2352x1568px
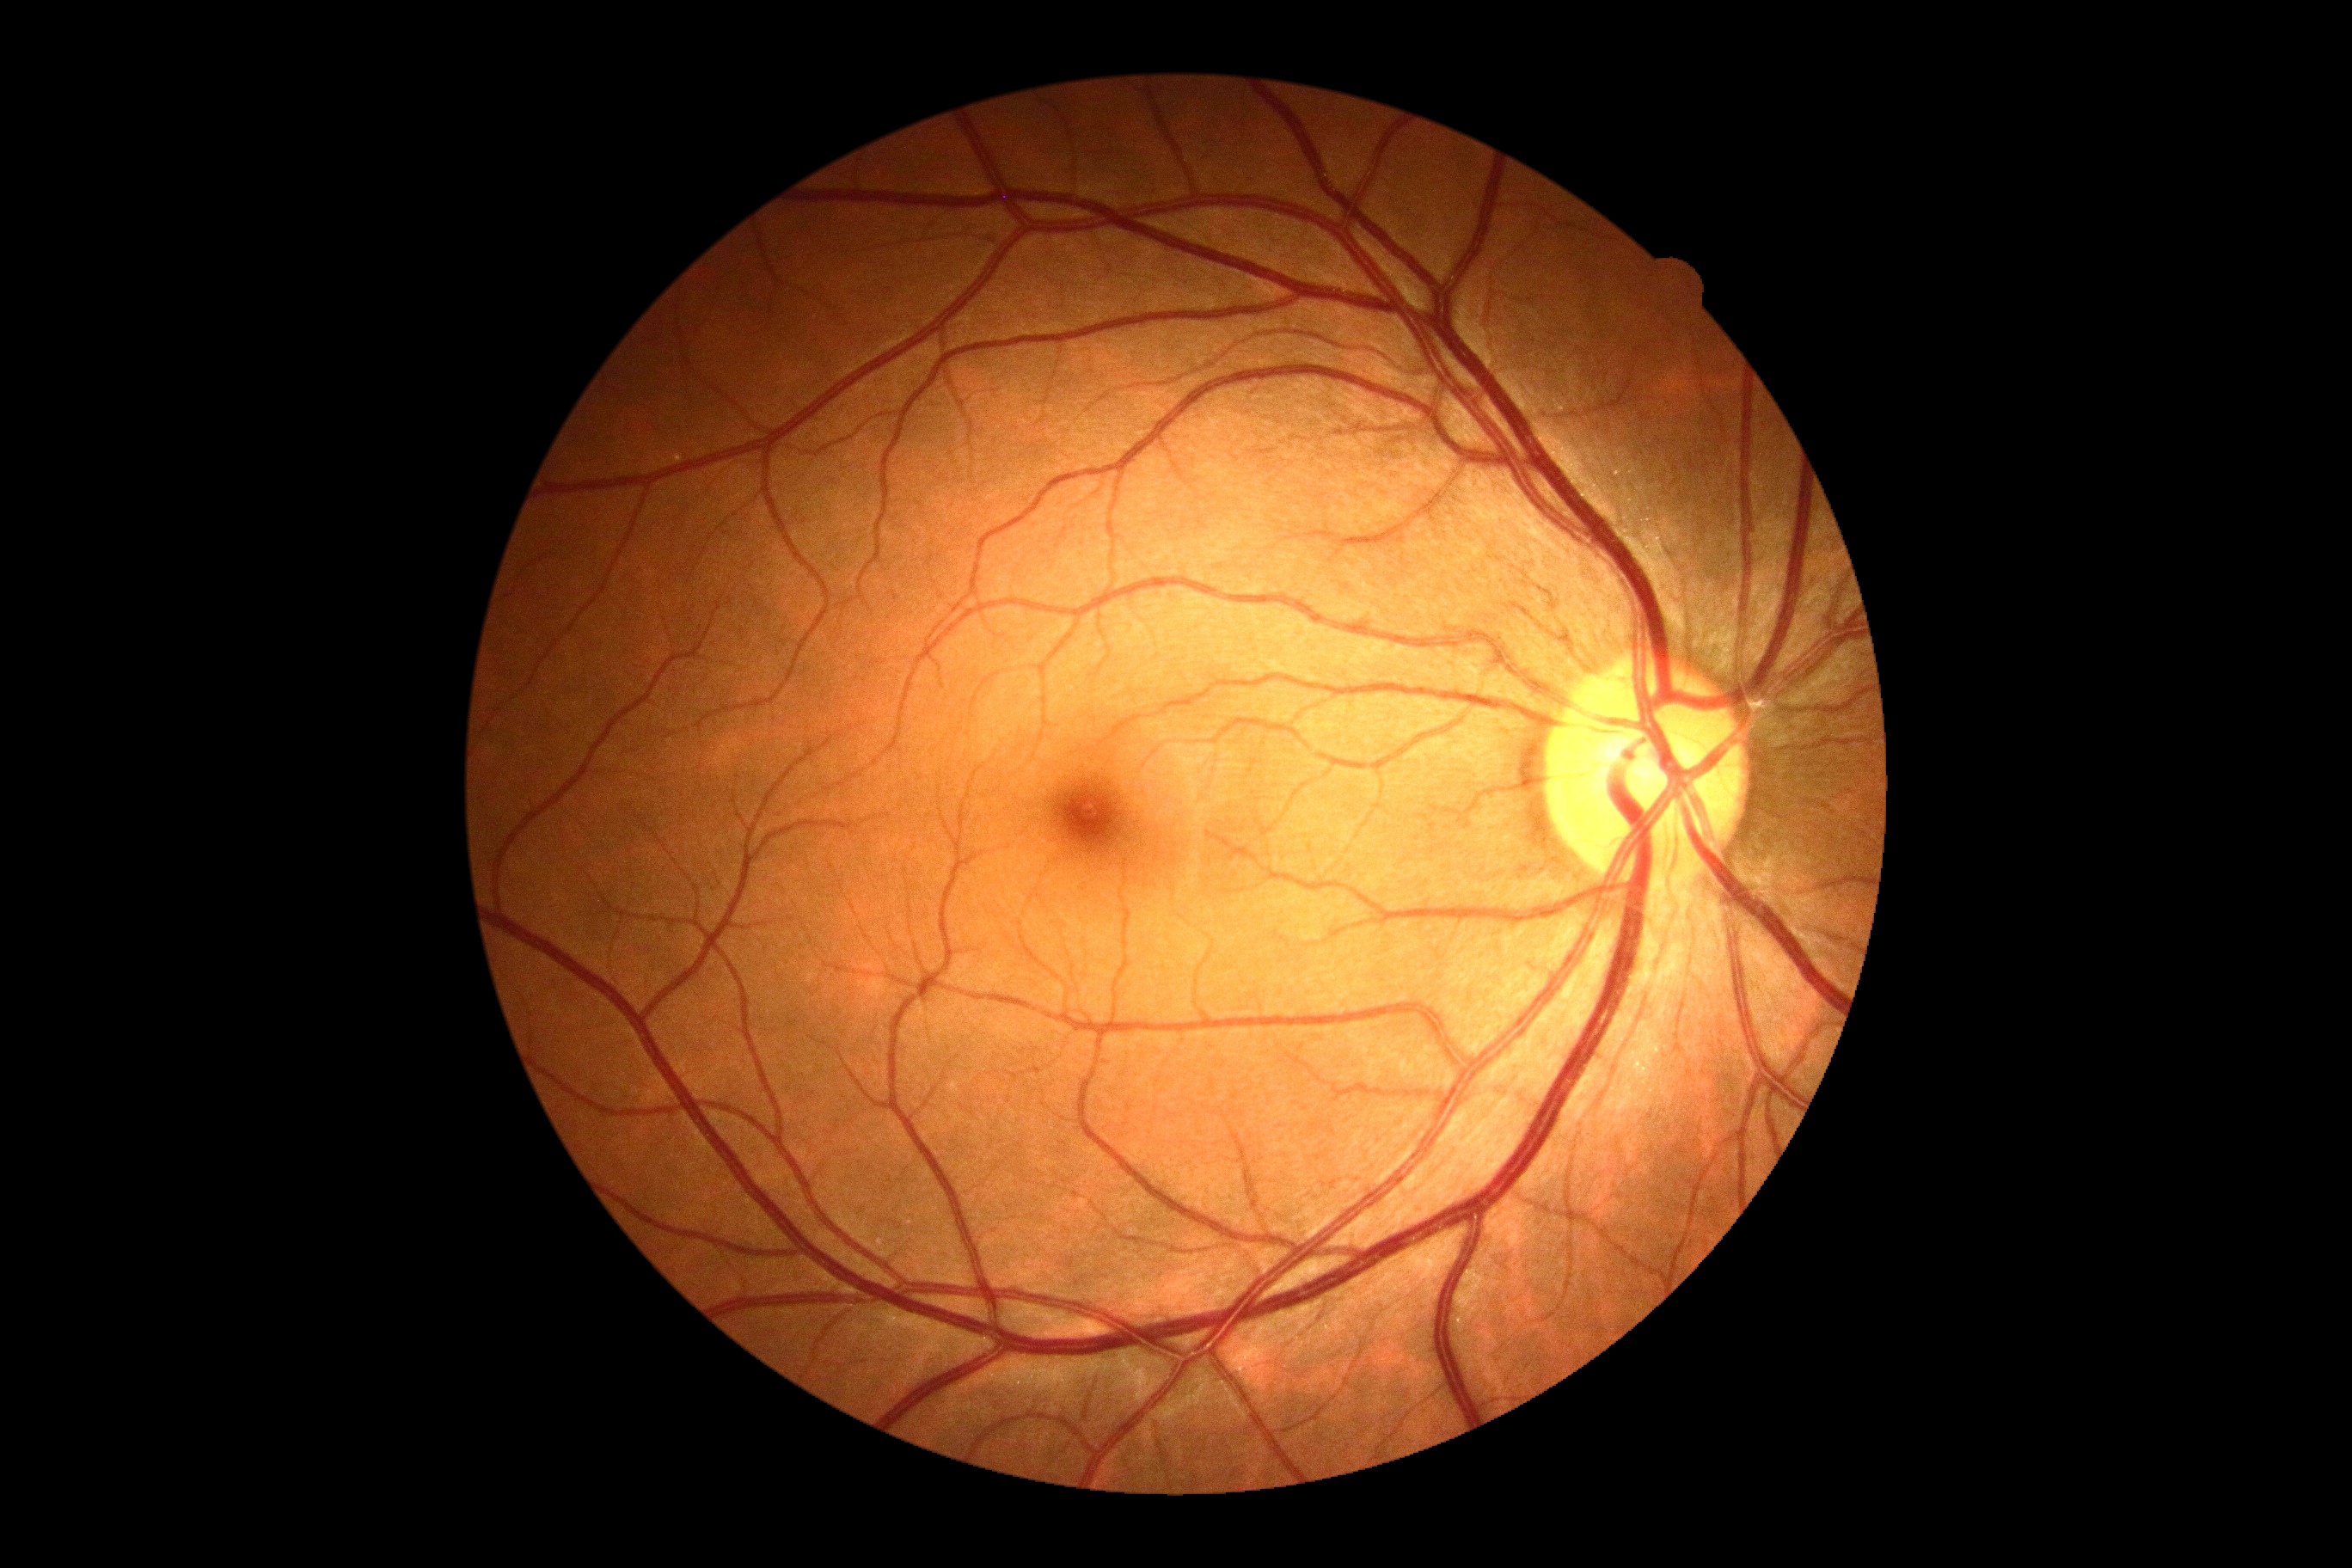

DR impression@no apparent DR, DR stage@0.